Captured with the Clarity RetCam 3 (130° field of view). Infant wide-field retinal image — 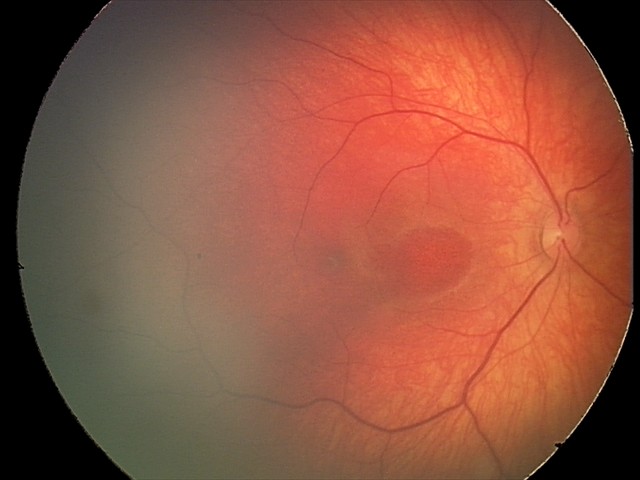 Diagnosis: retinal hemorrhages.